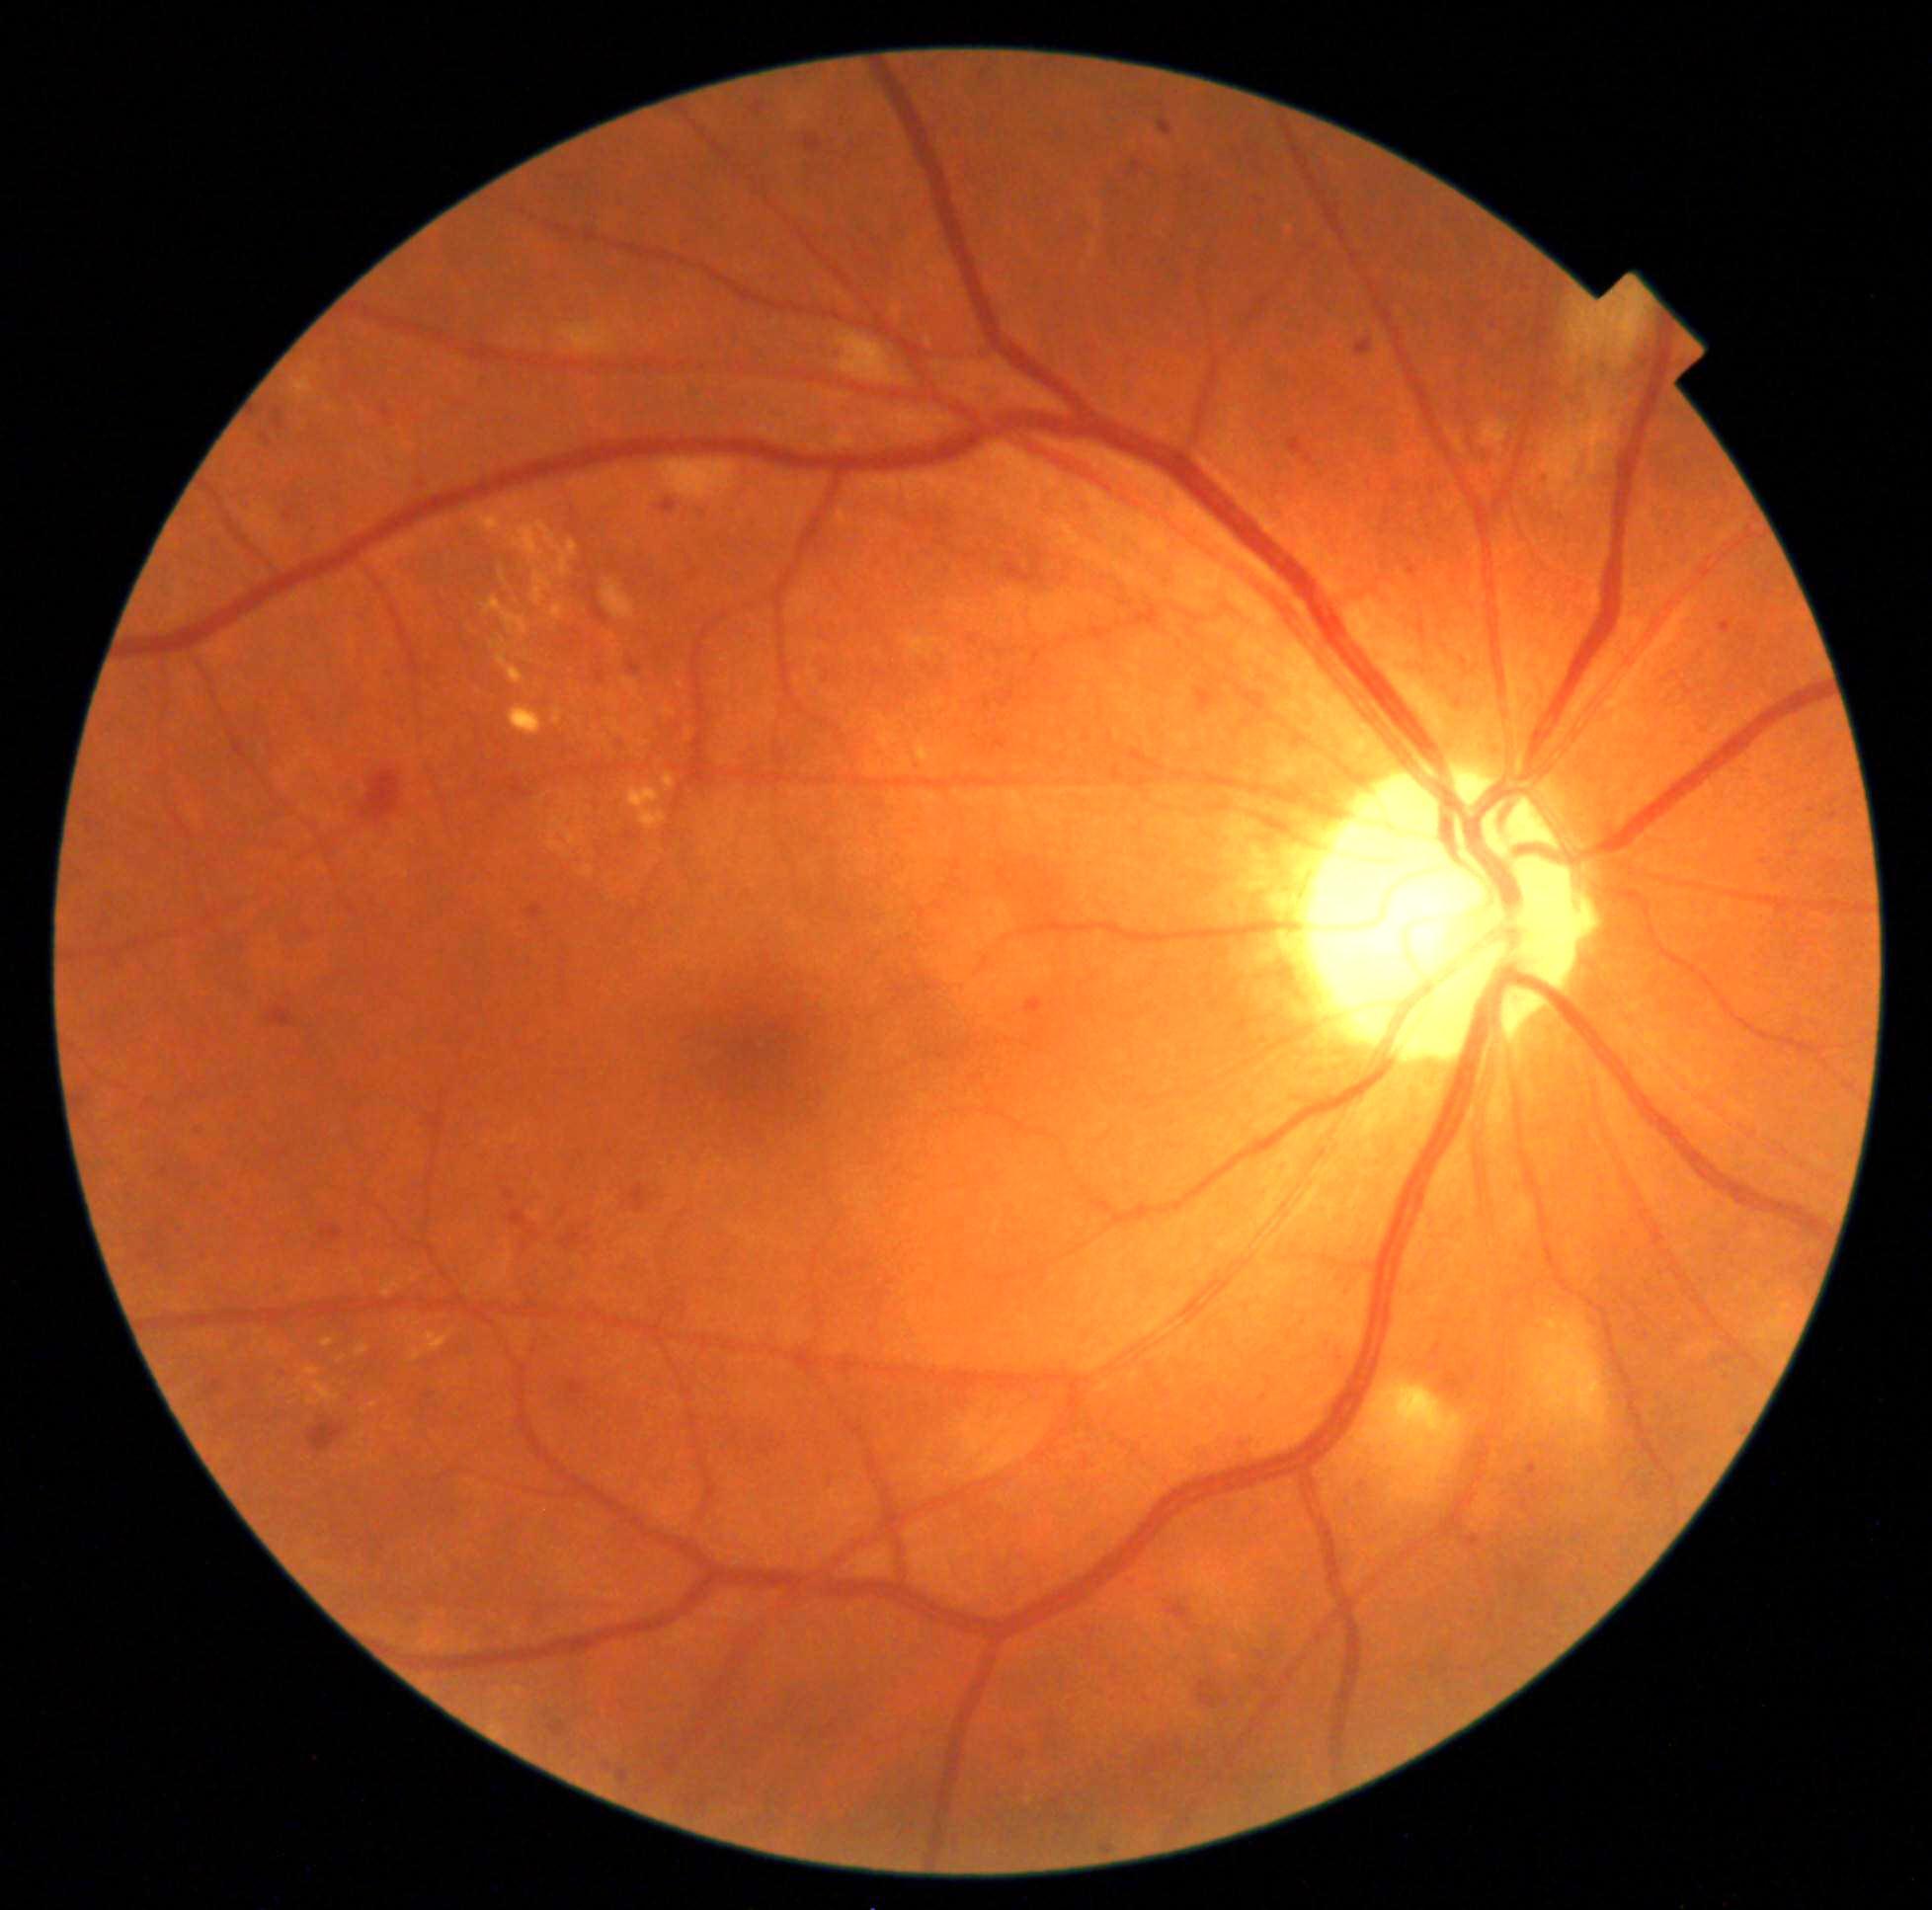 Disease class: non-proliferative diabetic retinopathy.
Diabetic retinopathy severity: moderate NPDR (grade 2).